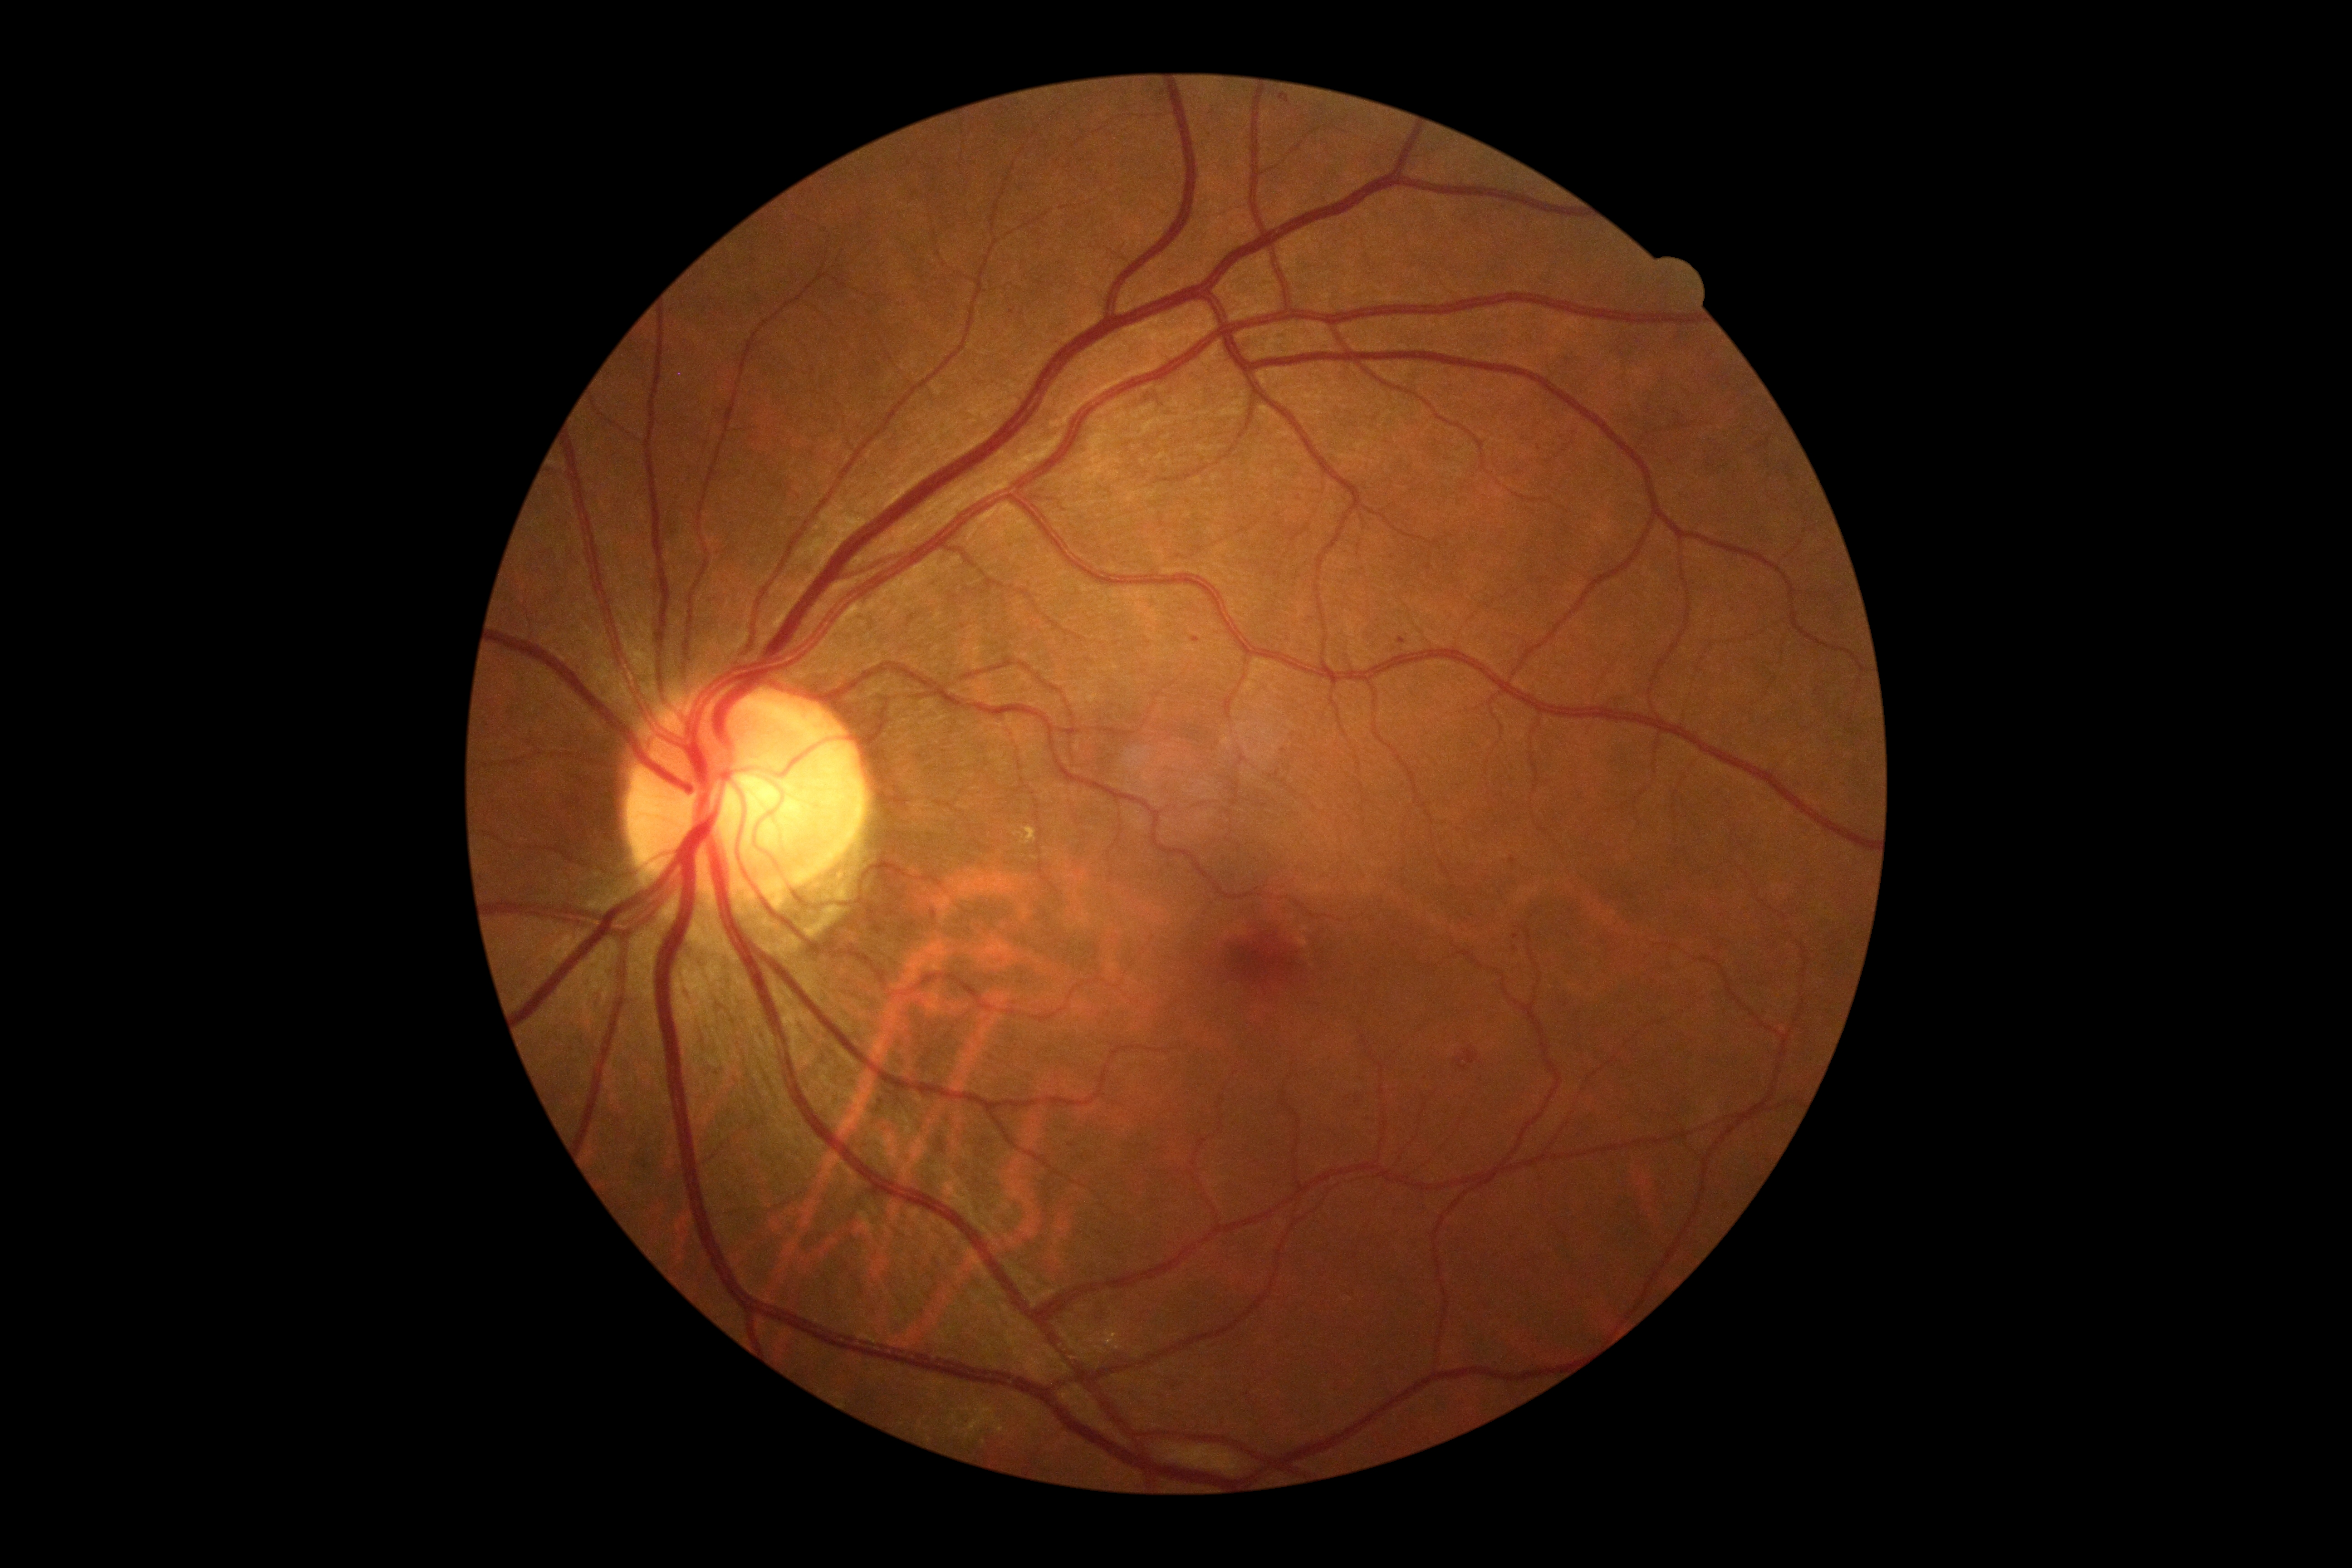 DR severity@grade 2 (moderate NPDR); DR class@non-proliferative diabetic retinopathy.